Color fundus image; 2048x1536px; 45° FOV
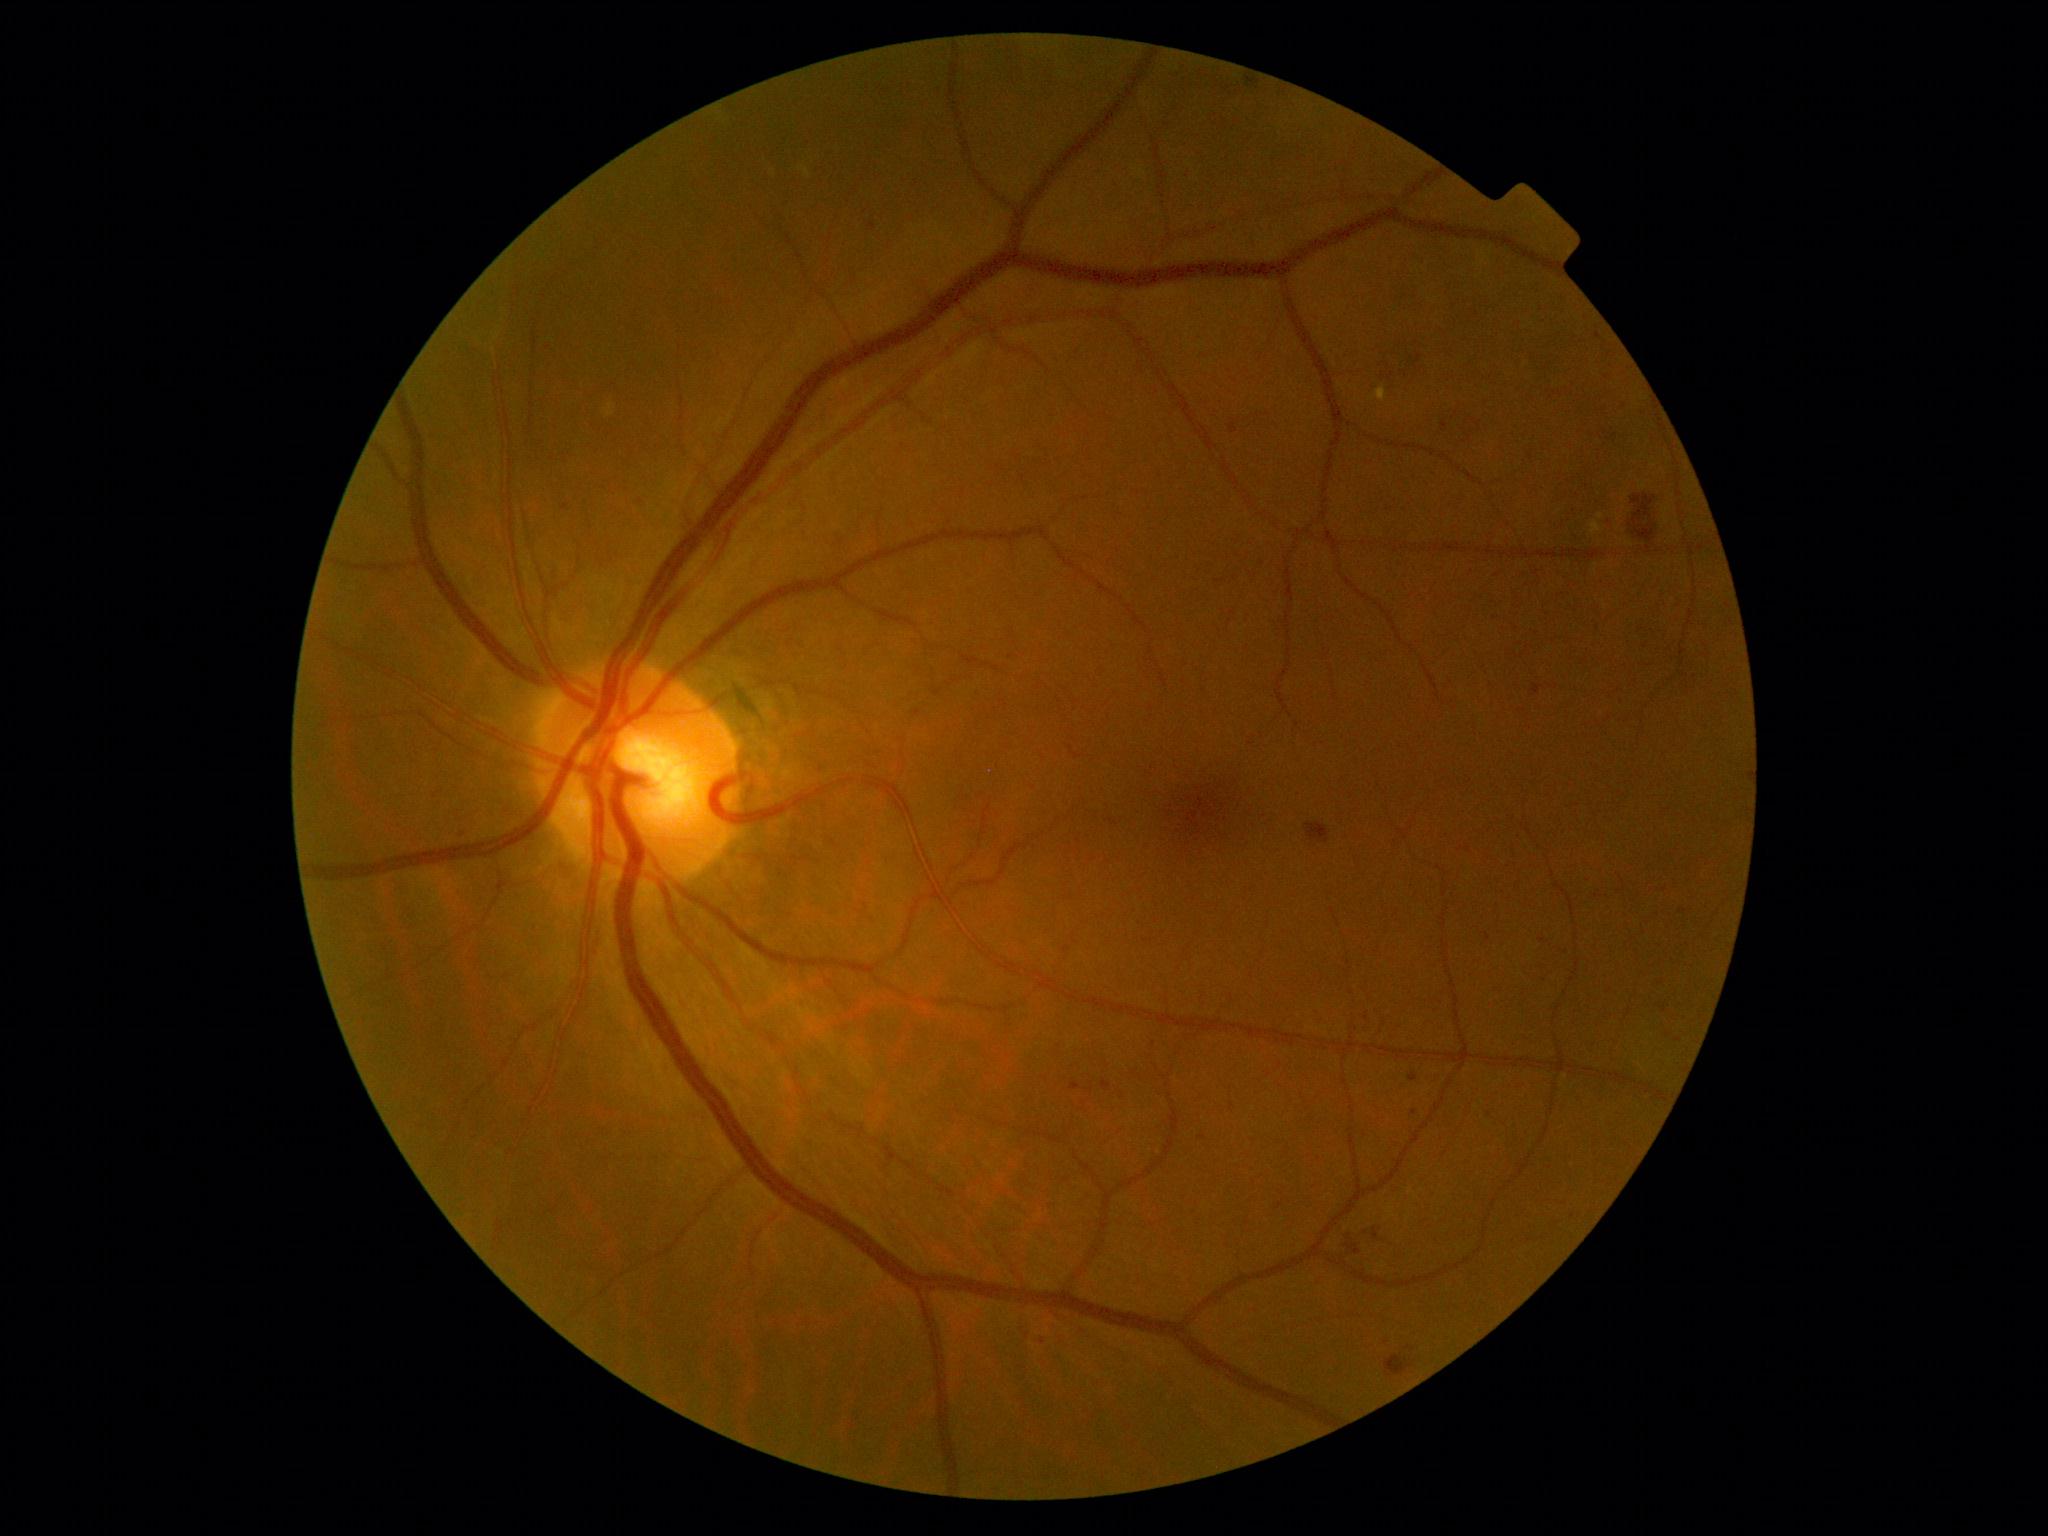
{"dr_grade": 2, "dr_grade_name": "moderate NPDR", "lesions": {"se": null, "ma": [[1485, 934, 1492, 942], [1102, 1080, 1112, 1092], [1231, 423, 1238, 435], [869, 224, 876, 232], [1070, 1083, 1081, 1092], [1409, 1074, 1419, 1082], [1532, 684, 1543, 694], [1041, 1338, 1046, 1346]], "ma_small": [[1414, 1113], [1202, 1138], [464, 830]], "ex": [[1591, 522, 1602, 535], [799, 166, 812, 178], [1374, 387, 1387, 403]], "ex_small": [[1601, 517]], "he": [[1246, 77, 1261, 86], [1345, 1244, 1361, 1255], [1629, 494, 1657, 544], [1373, 1228, 1380, 1241], [1305, 823, 1330, 844], [1386, 1356, 1414, 1377]], "he_small": [[1350, 1238]]}}